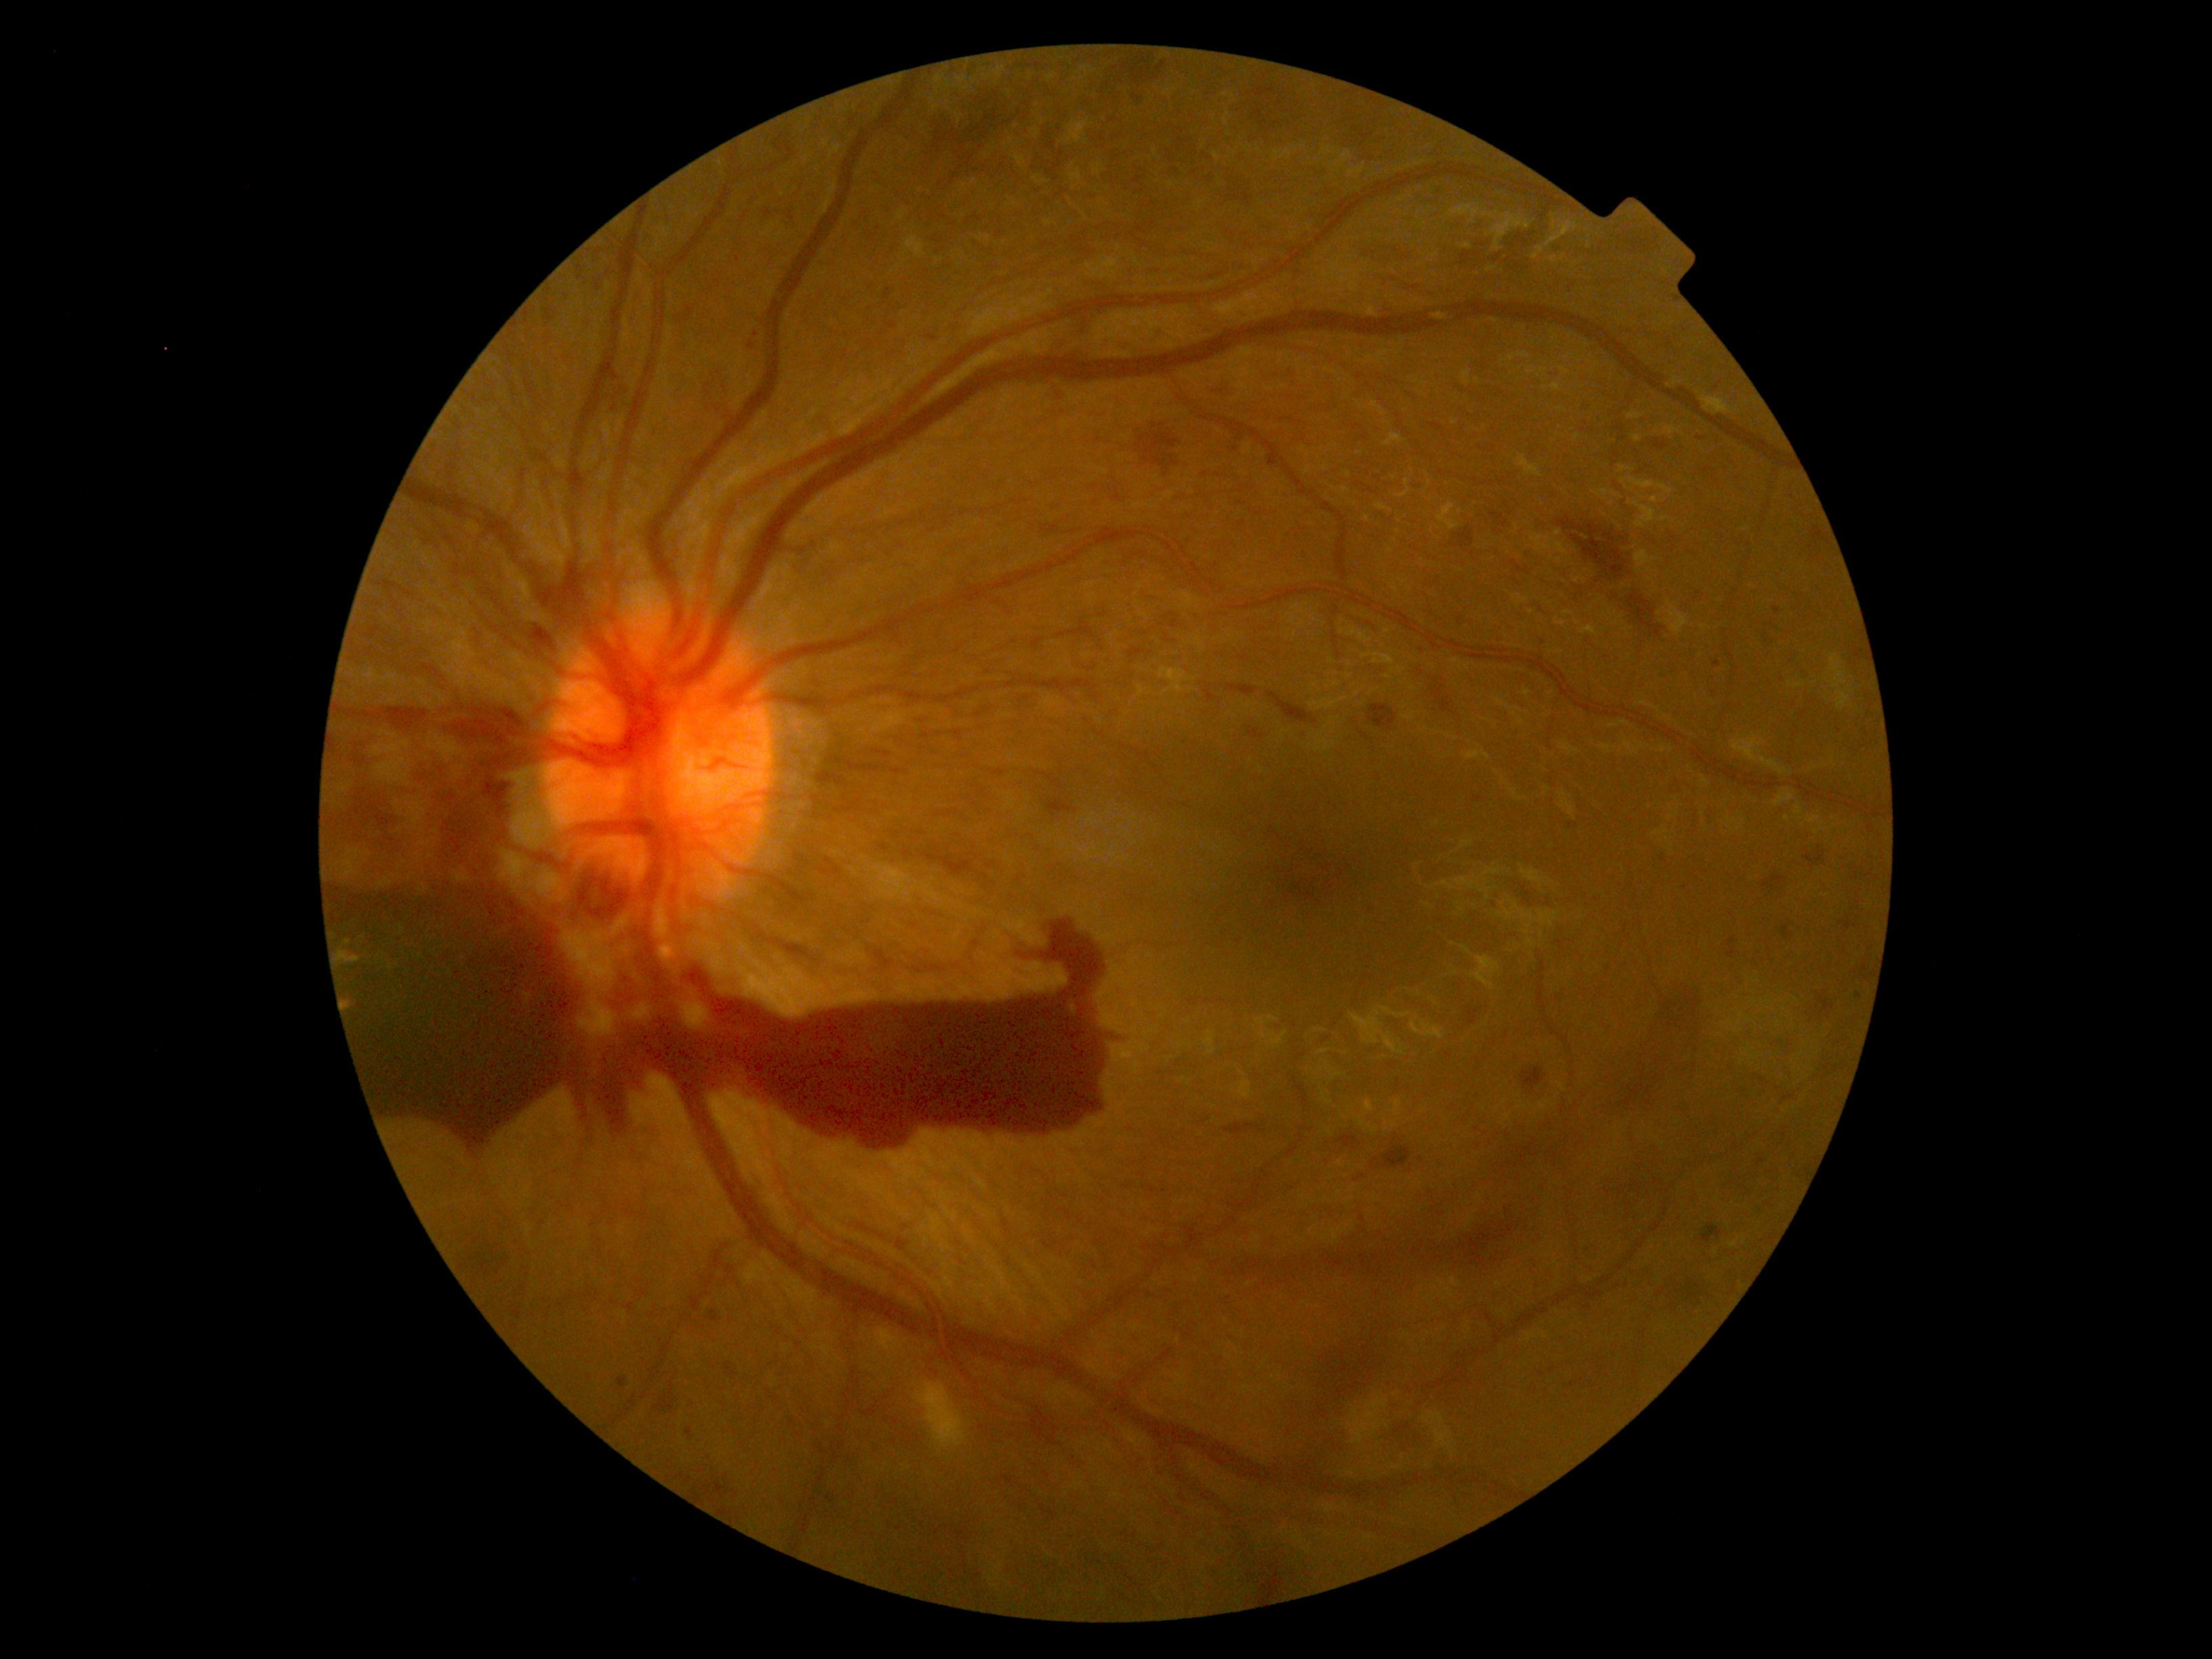
Diabetic retinopathy (DR) is 4/4. The retinopathy is classified as proliferative diabetic retinopathy.